2352x1568px · retinal fundus photograph:
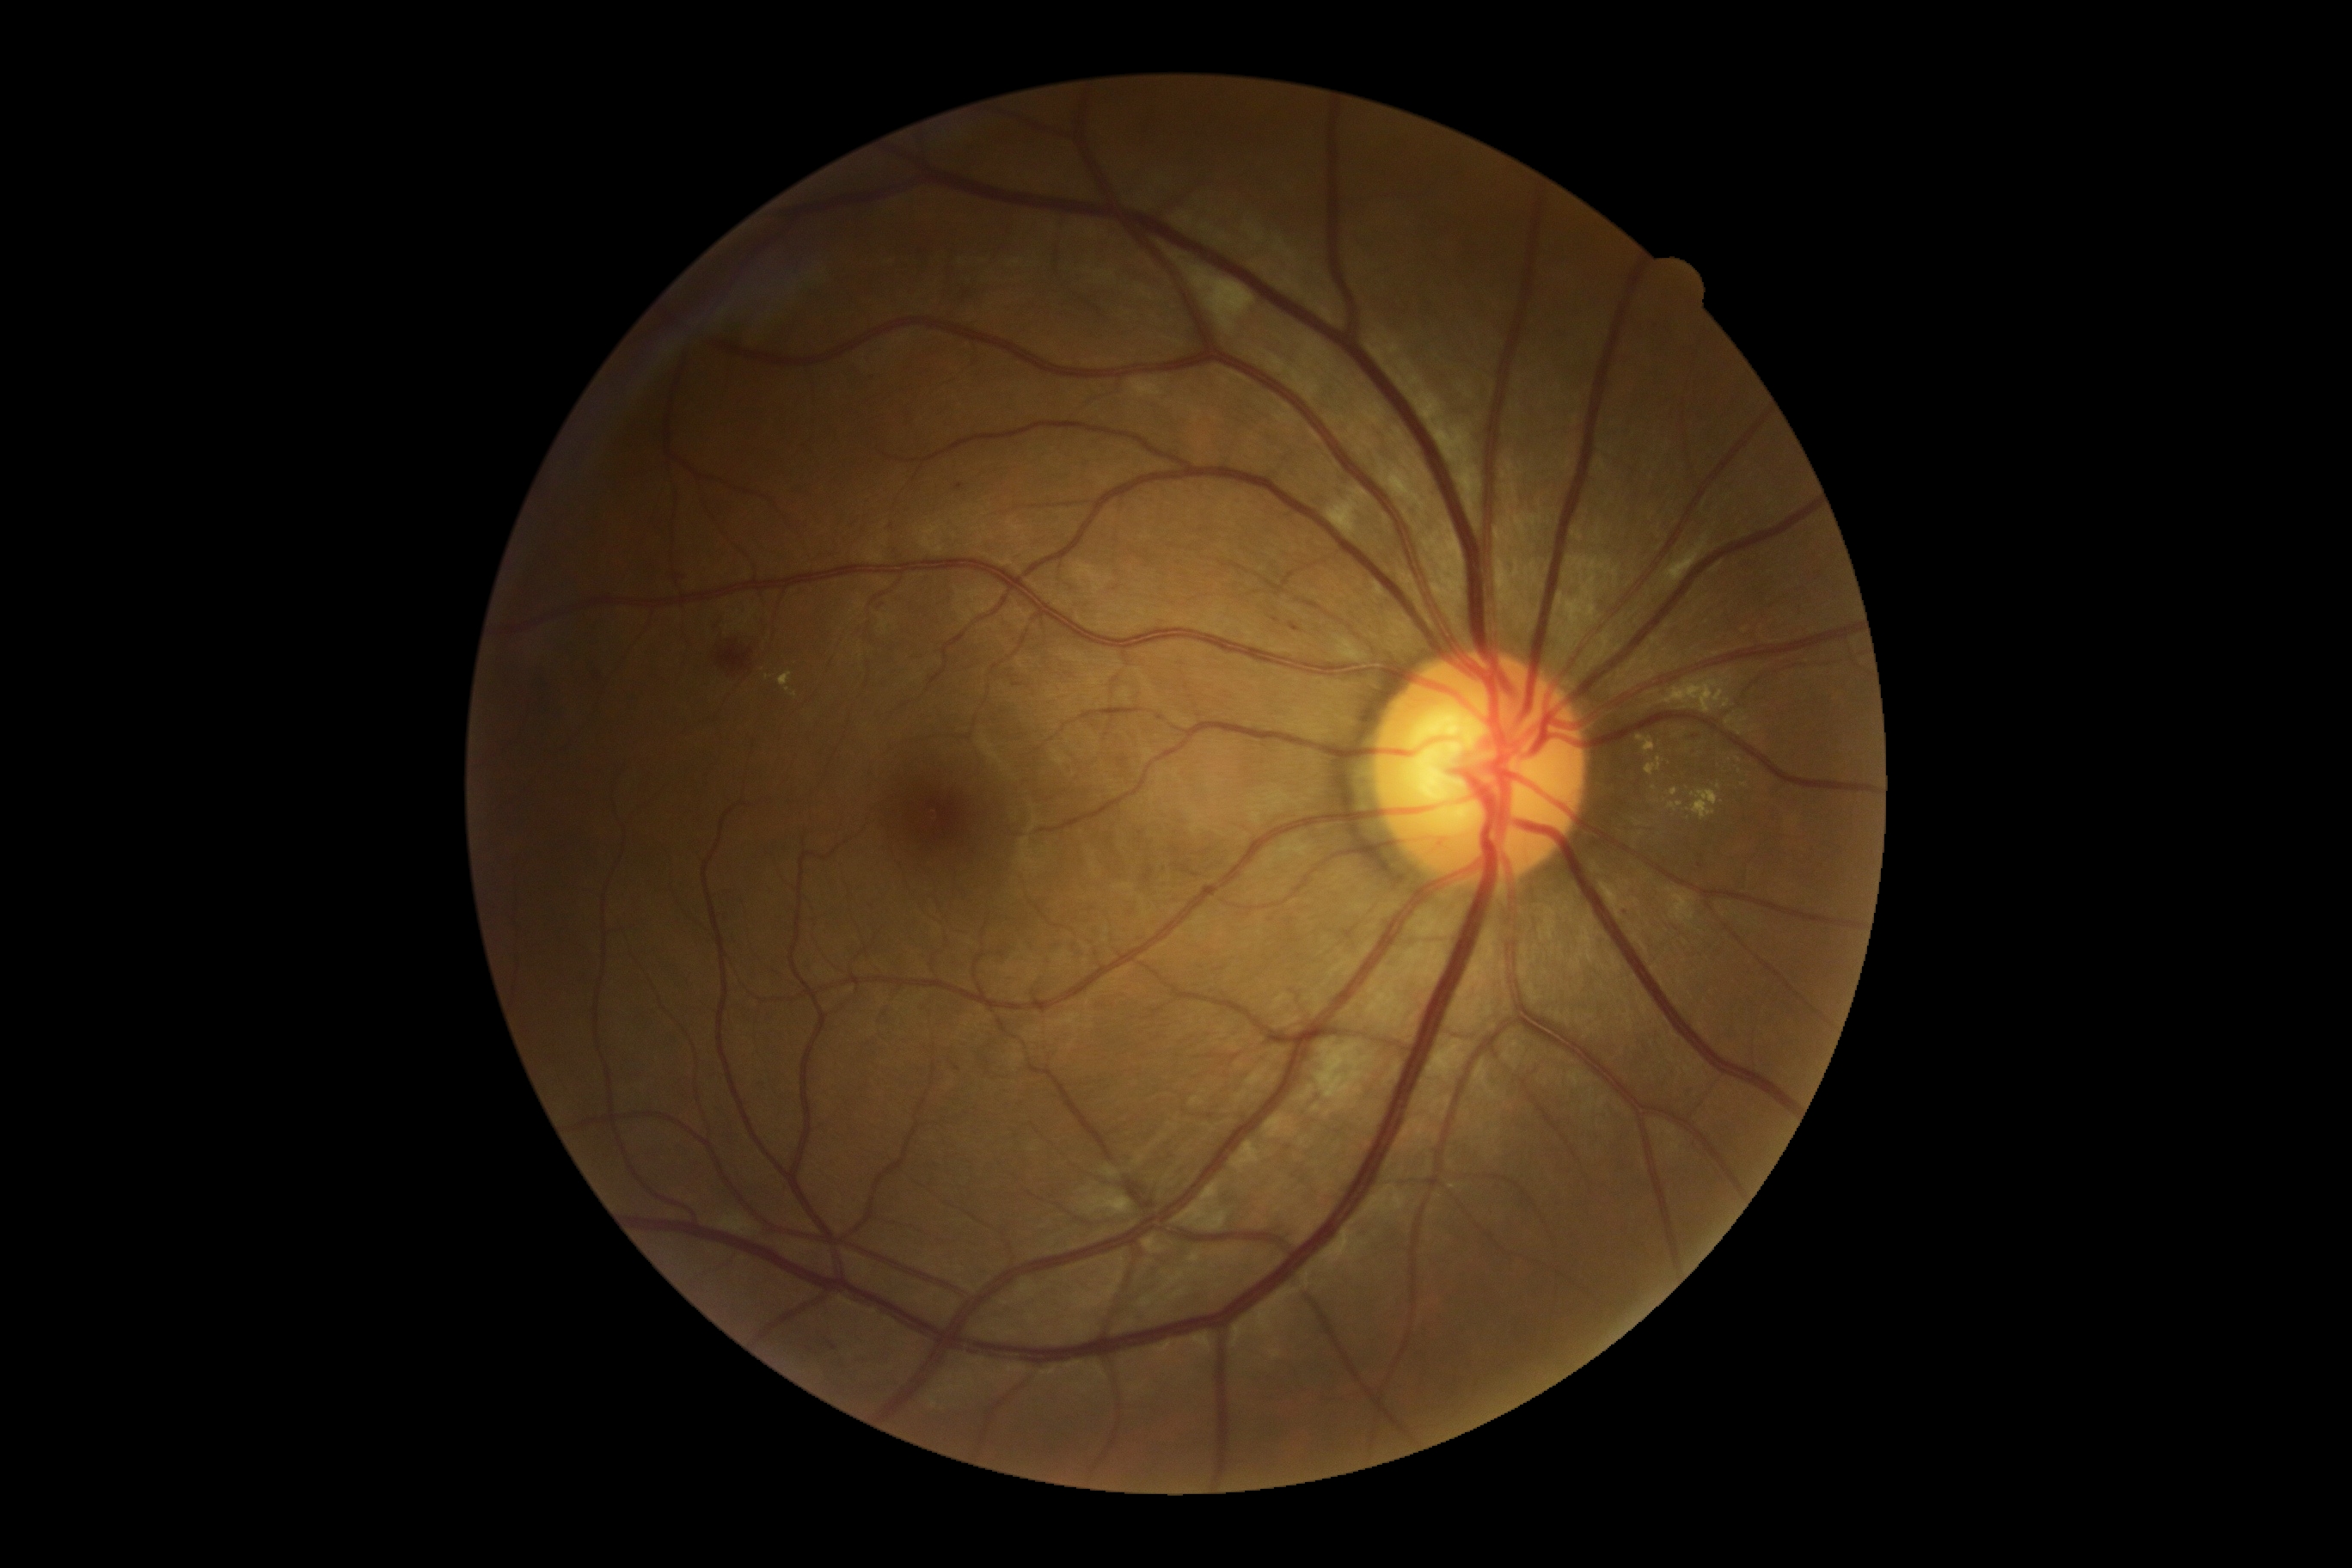

The retinopathy is classified as non-proliferative diabetic retinopathy. DR severity: grade 2.